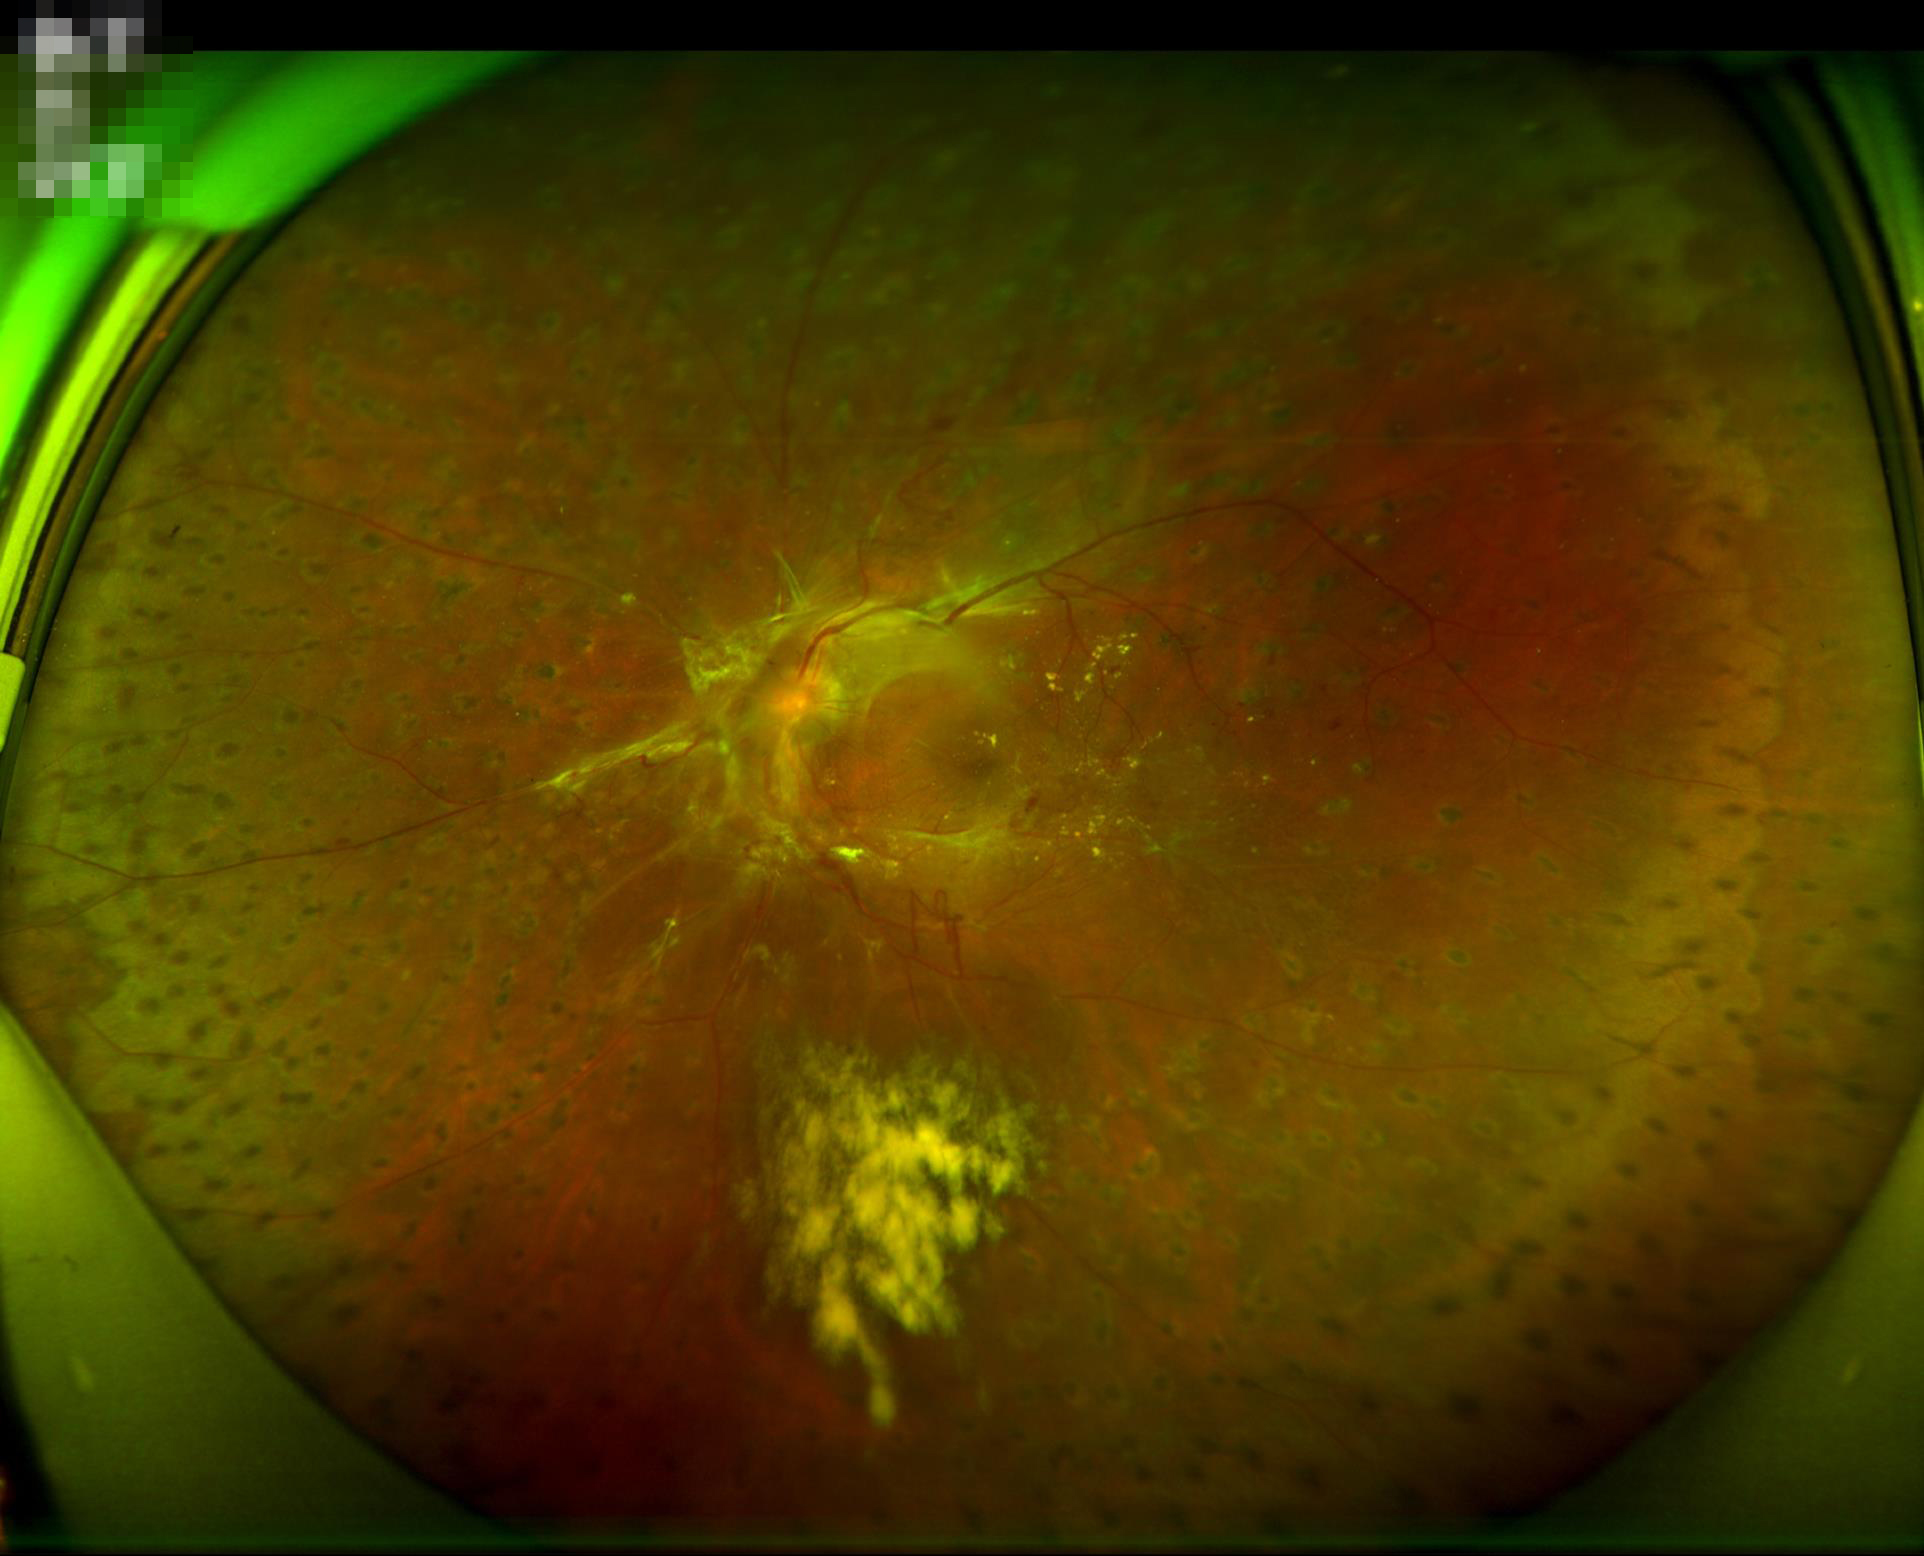 Optic disc, vessels, and background are in focus. Adequate contrast for distinguishing structures. Overall quality is poor; the image is difficult to grade.